2352 x 1568 pixels: 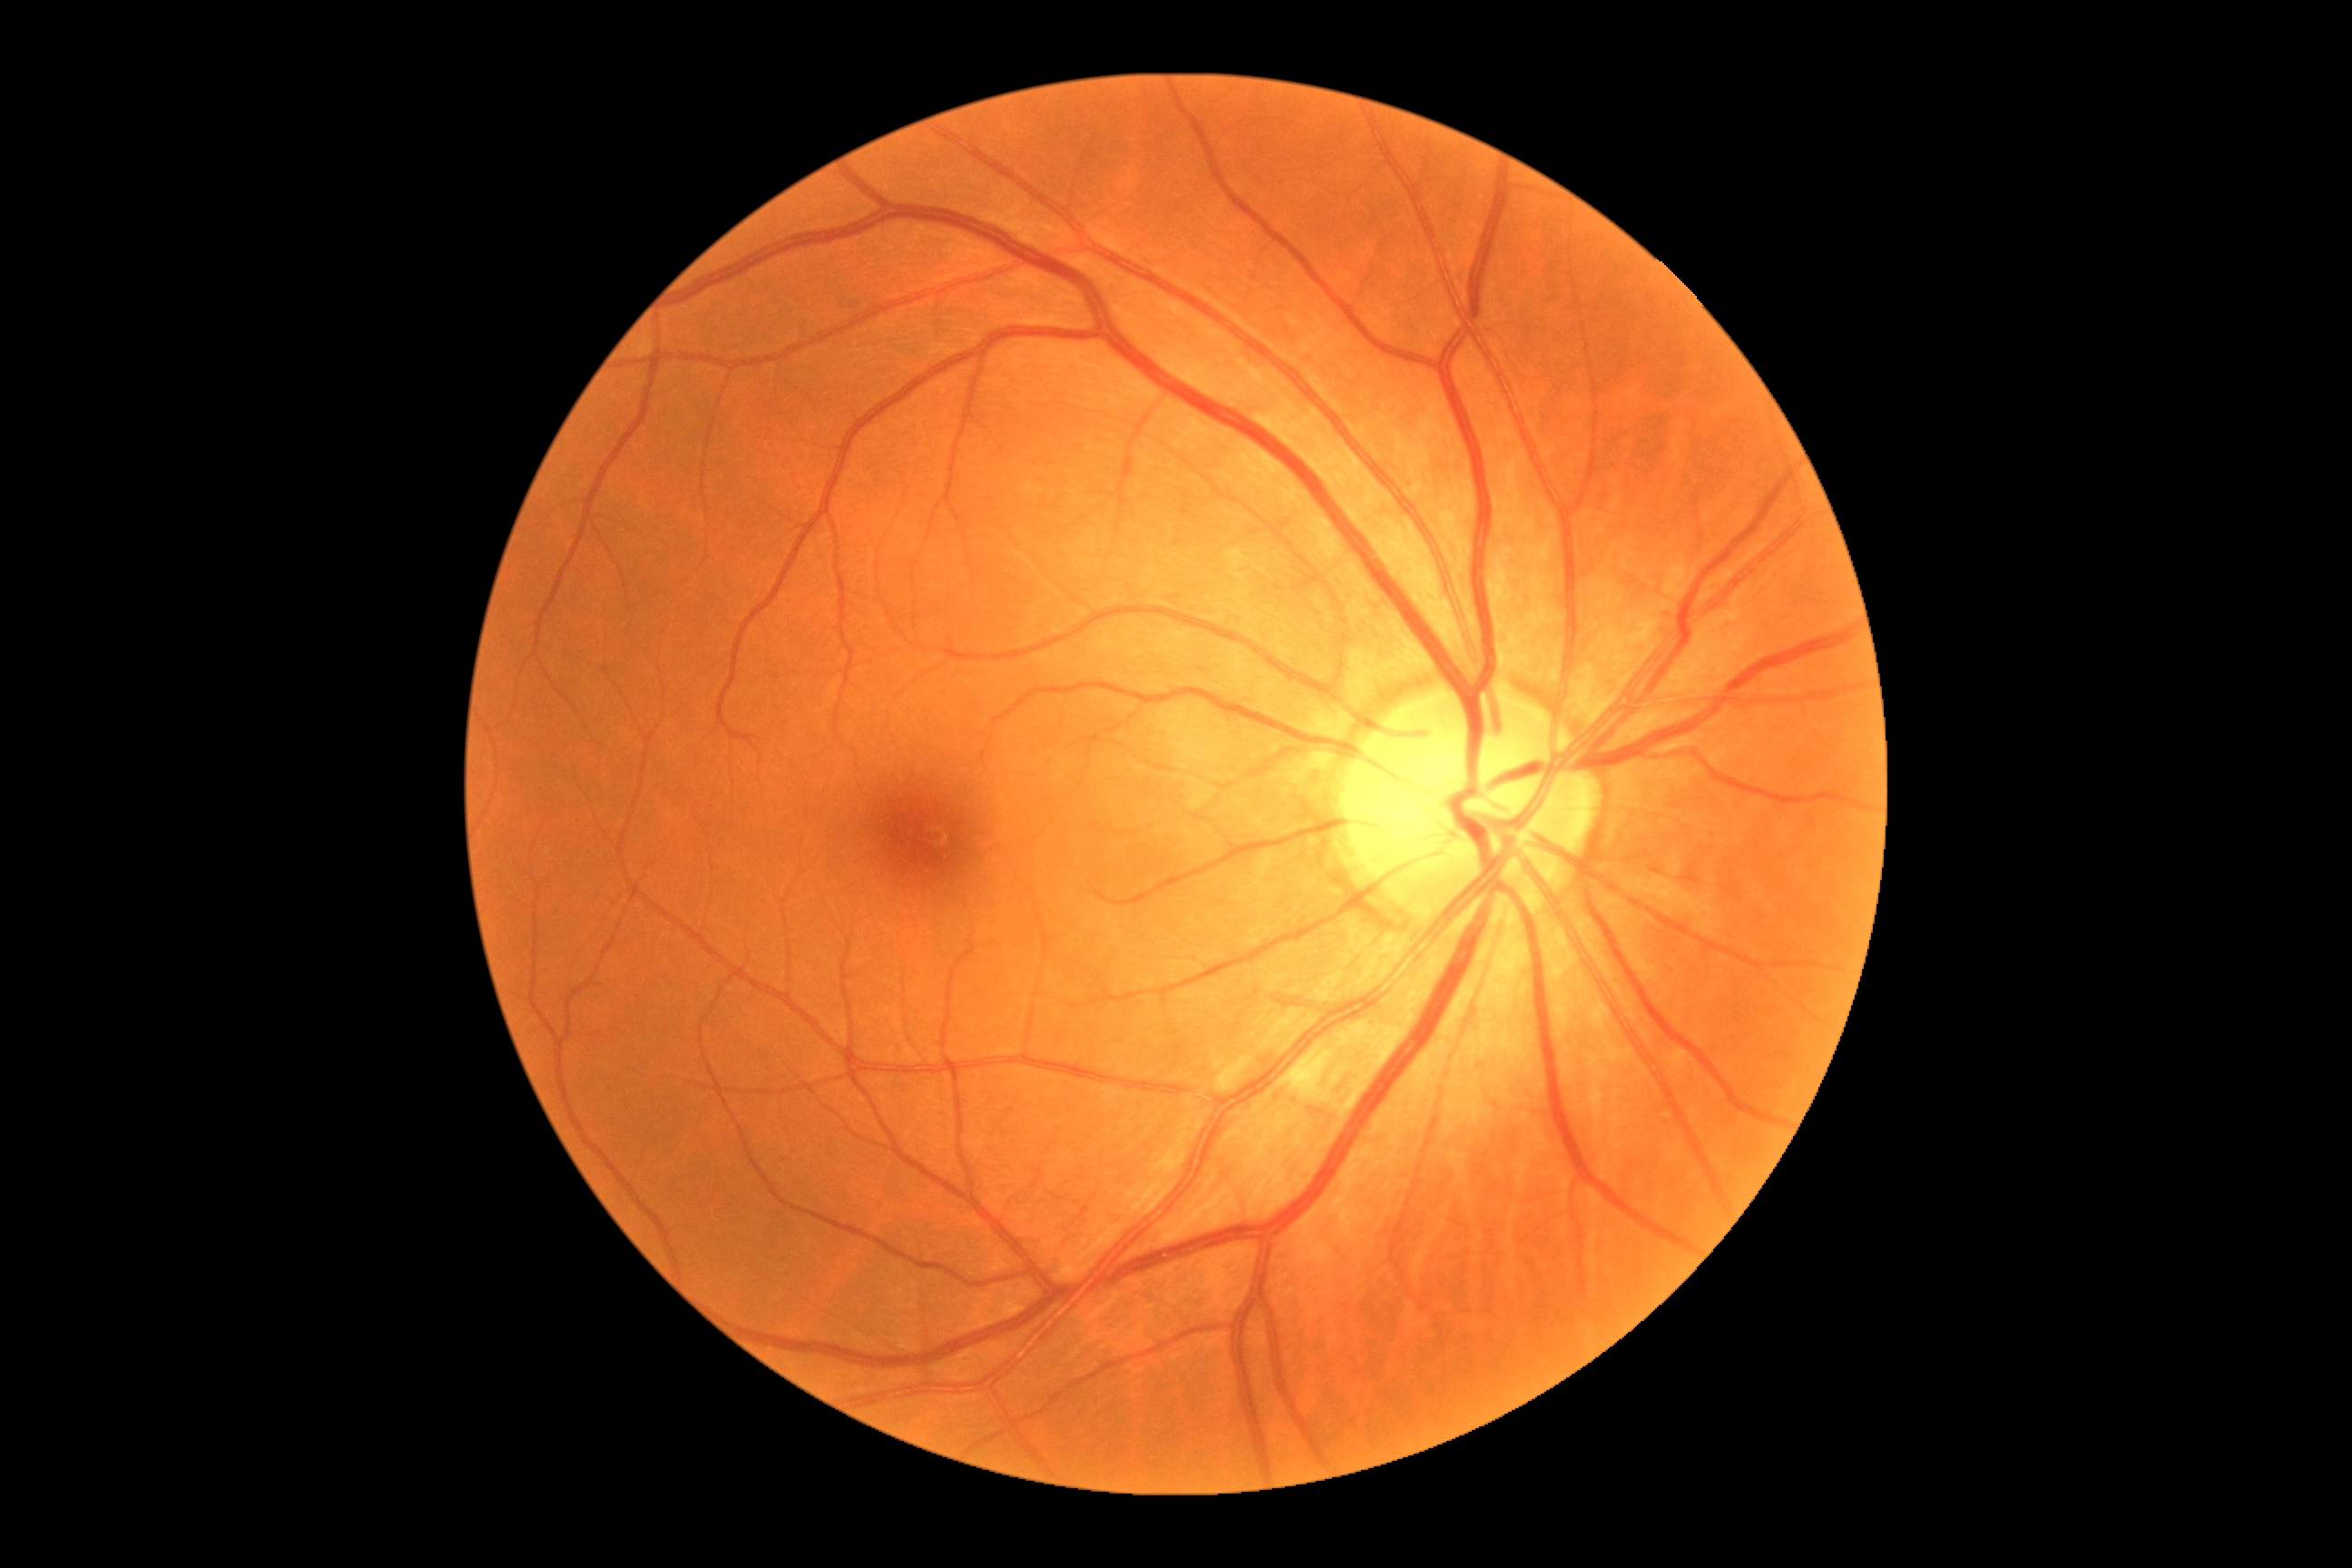
• DR grade: 0 (no apparent retinopathy)